Color fundus image, camera: Nidek AFC-330: 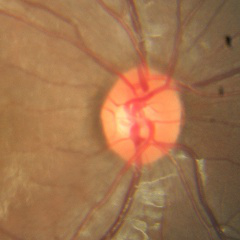 There is evidence of no glaucoma.